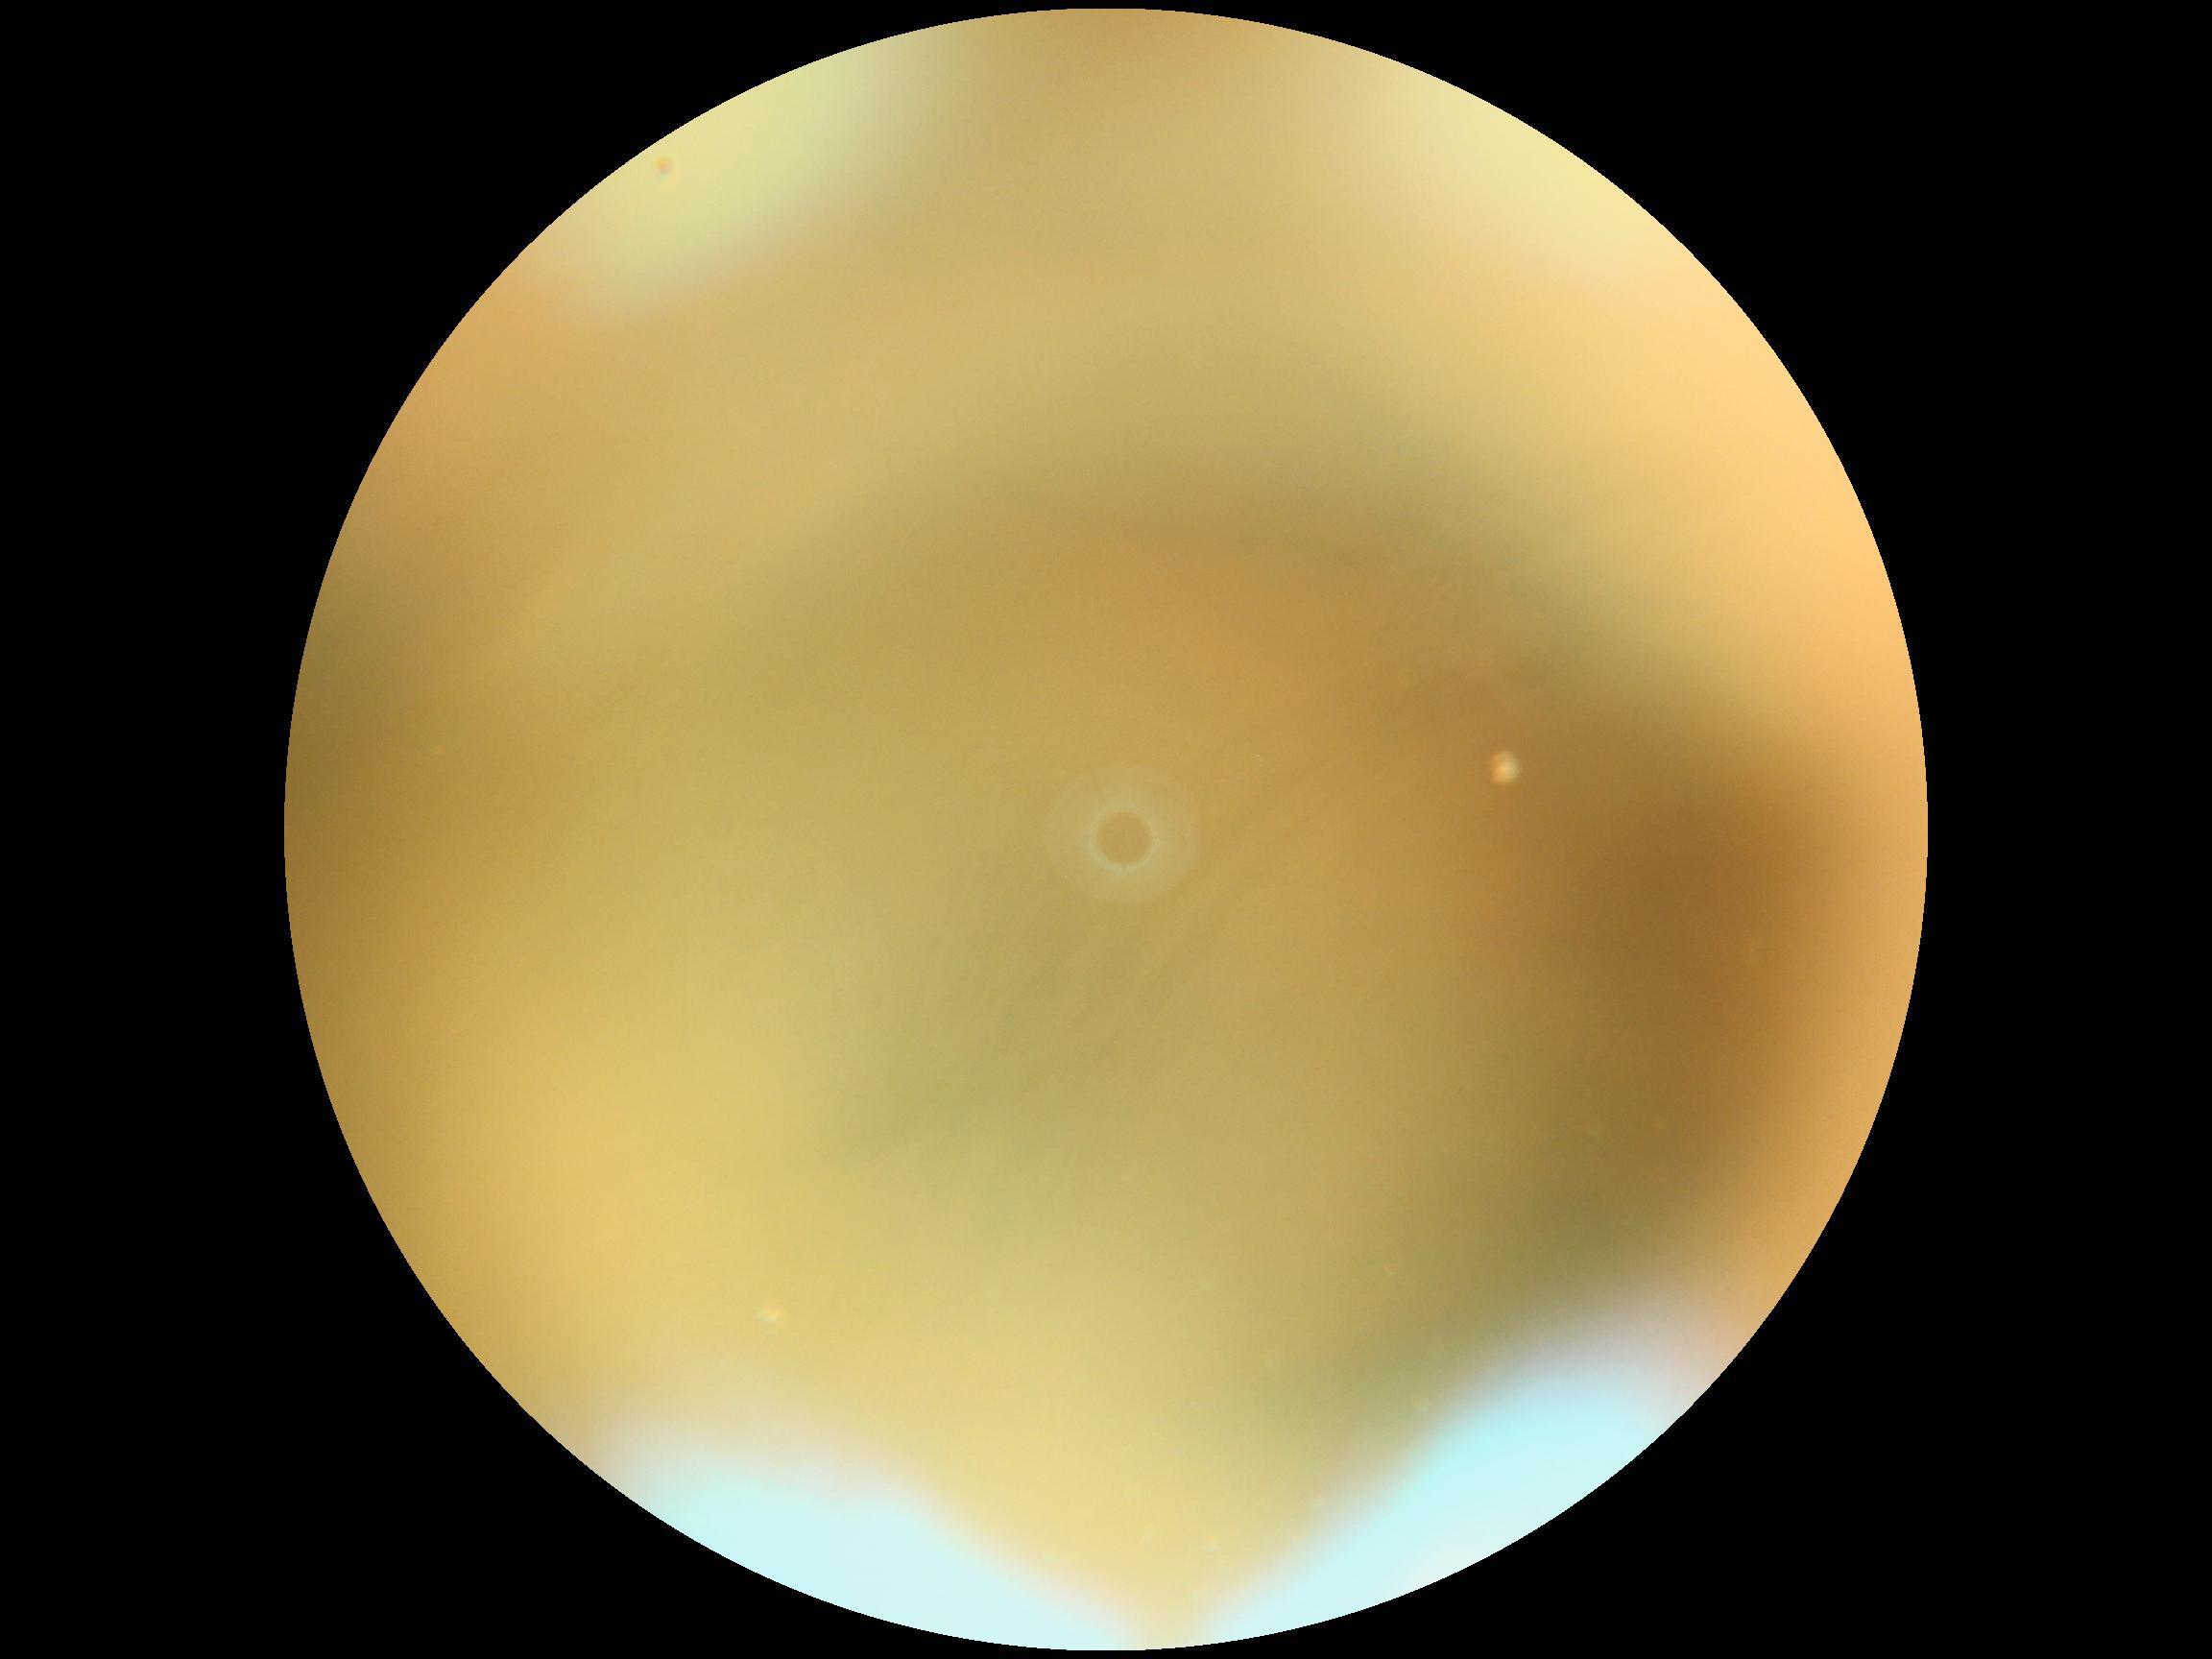

DR is ungradable due to poor image quality.